Acquired with a NIDEK AFC-230: 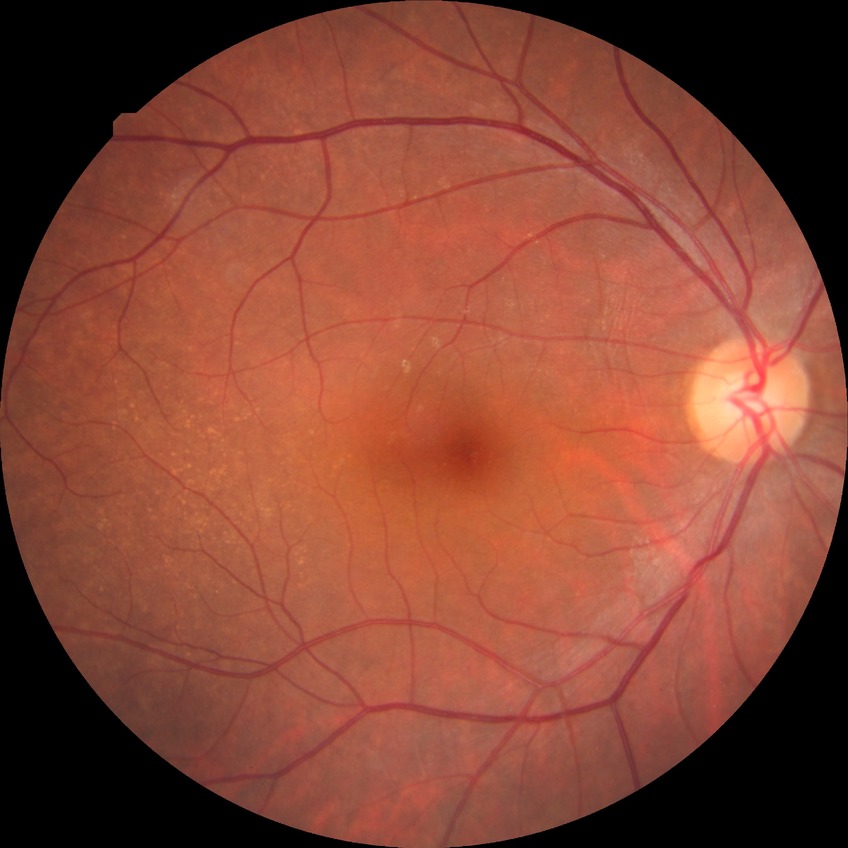
DR severity is NDR.